45° field of view · fundus photo · 2352 by 1568 pixels:
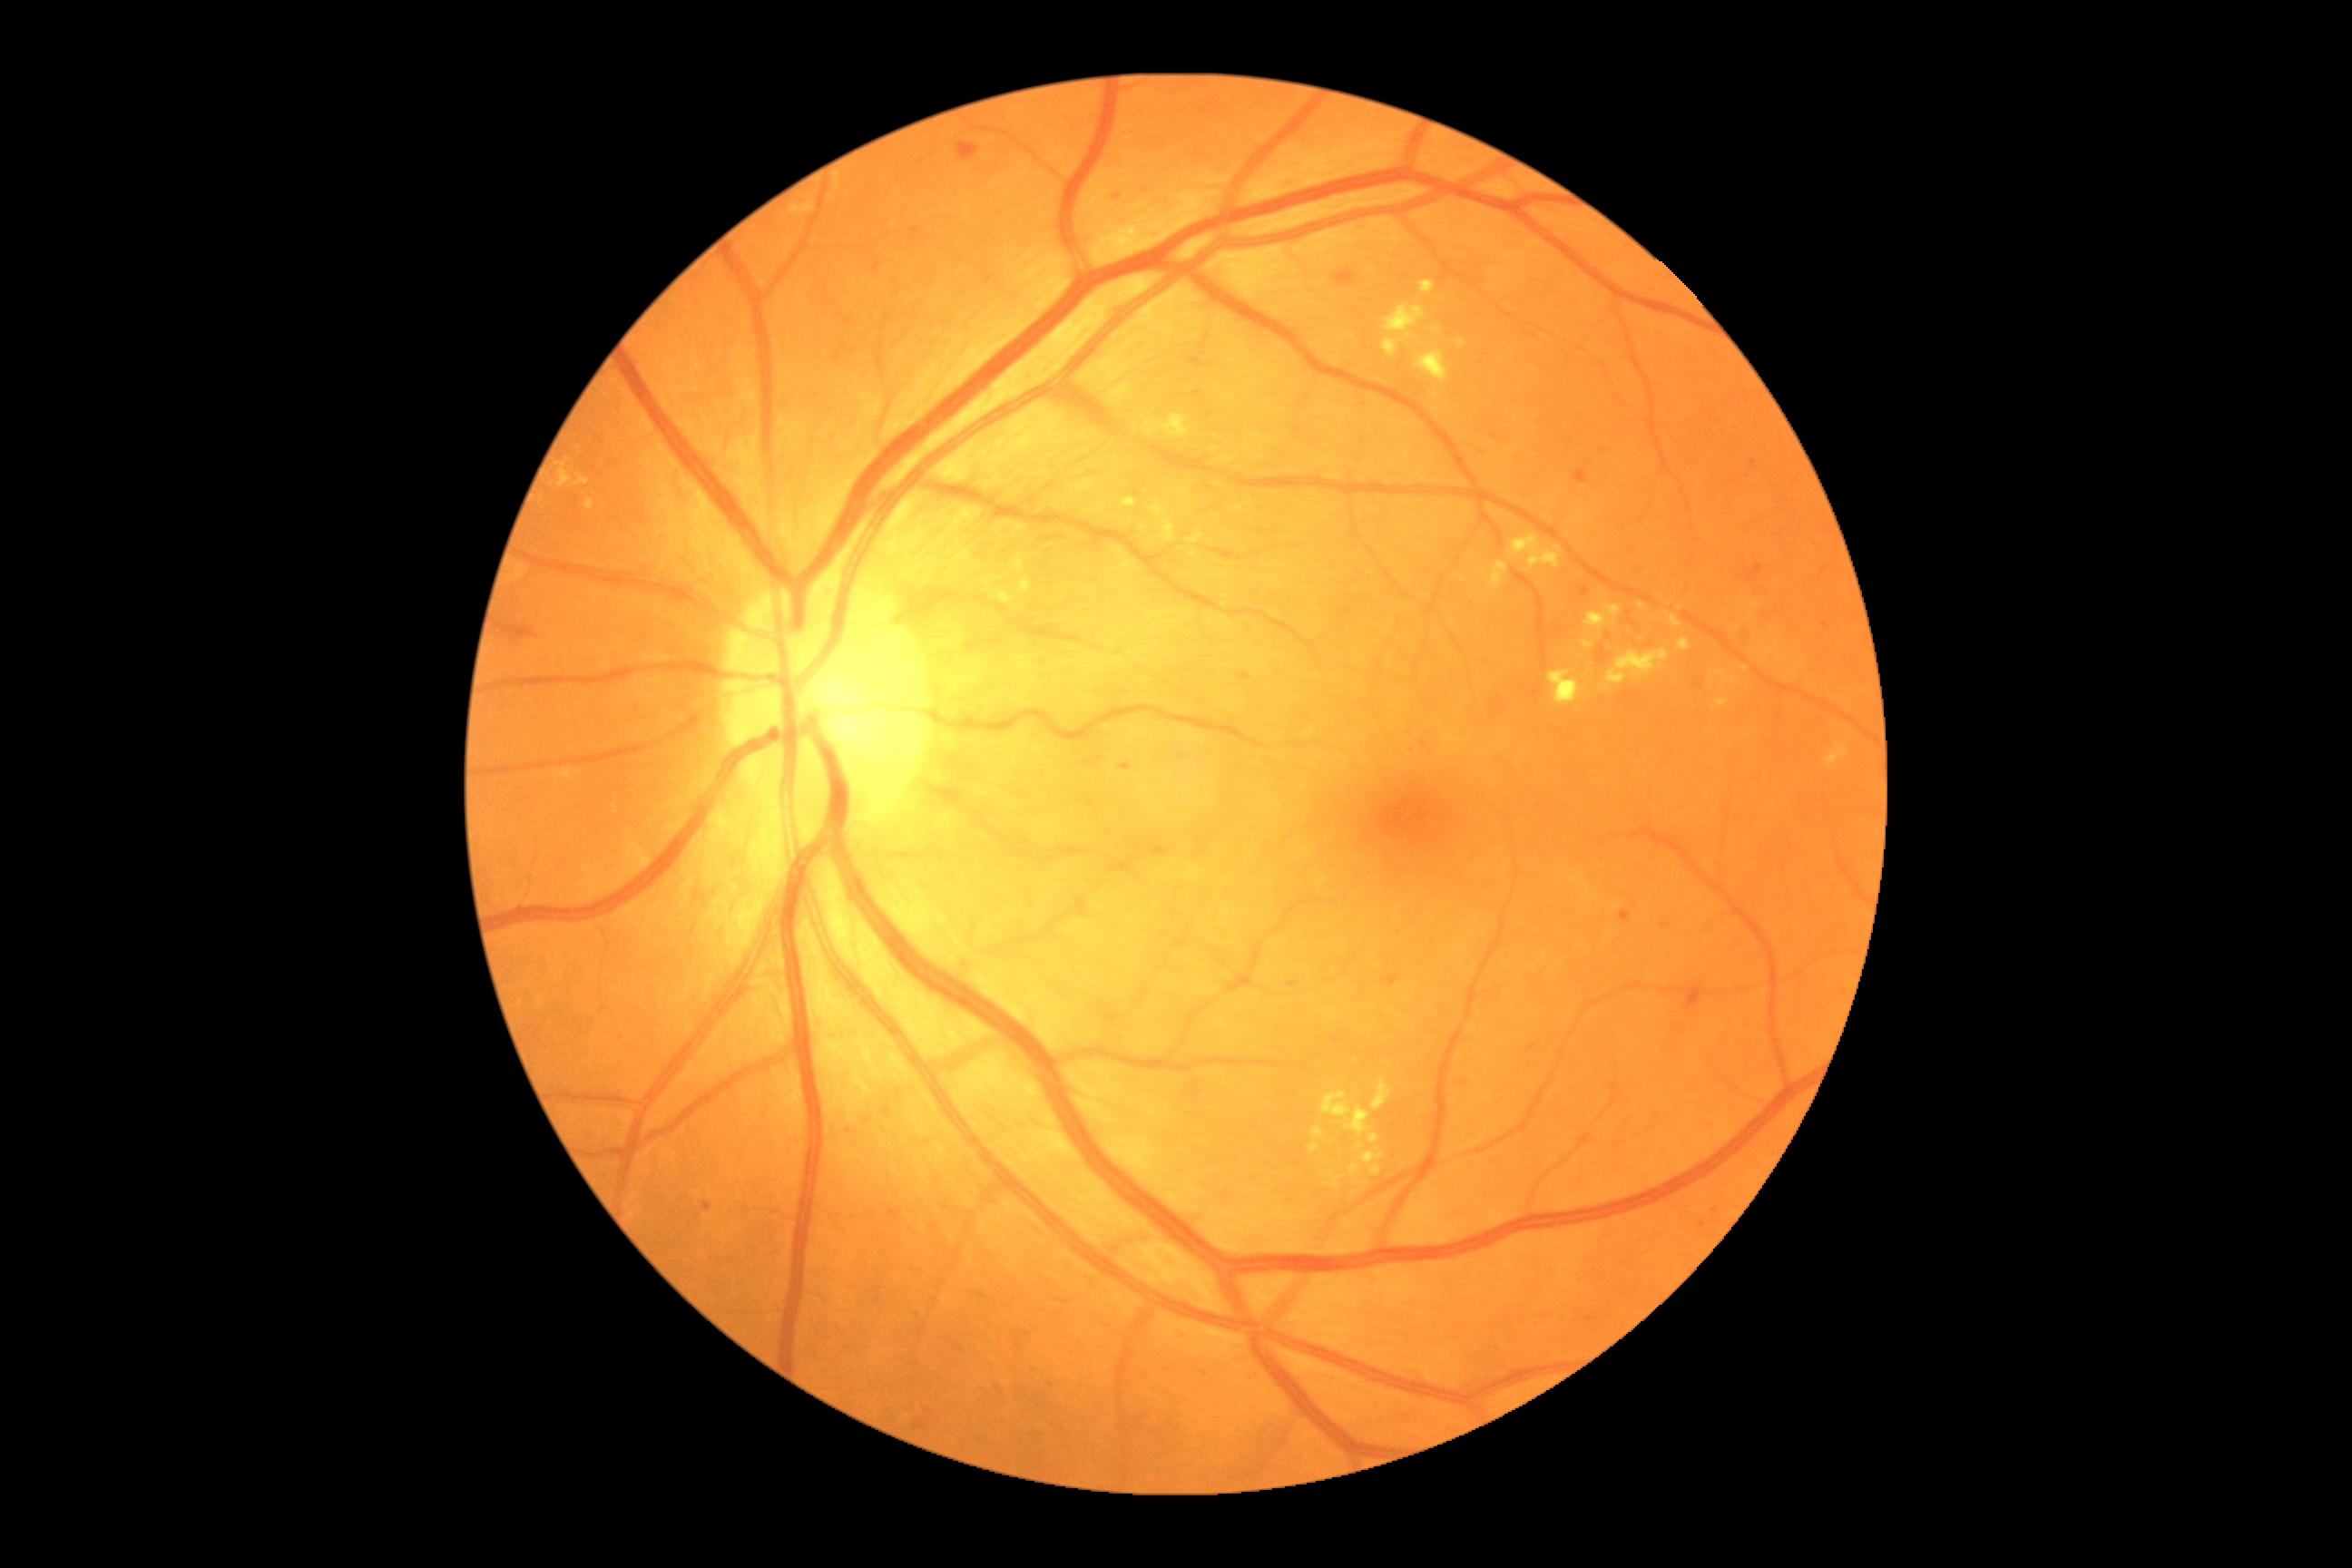 partial: true
dr_grade: 2
dr_grade_name: moderate NPDR
lesions:
  ex:
    - (x1=1150, y1=504, x2=1166, y2=518)
    - (x1=1547, y1=671, x2=1587, y2=707)
    - (x1=1188, y1=531, x2=1202, y2=545)
    - (x1=1181, y1=487, x2=1191, y2=498)
    - (x1=1716, y1=672, x2=1725, y2=676)
    - (x1=558, y1=458, x2=591, y2=487)
    - (x1=1211, y1=447, x2=1219, y2=453)
    - (x1=1309, y1=1144, x2=1320, y2=1153)
    - (x1=1456, y1=338, x2=1465, y2=348)
    - (x1=1825, y1=743, x2=1848, y2=769)
    - (x1=1607, y1=649, x2=1671, y2=685)
    - (x1=1714, y1=698, x2=1729, y2=710)
    - (x1=995, y1=593, x2=1012, y2=602)
    - (x1=1665, y1=612, x2=1683, y2=631)
    - (x1=1582, y1=642, x2=1594, y2=651)
  ex_small:
    - (x=1607, y=688)
    - (x=1436, y=331)
  ma:
    - (x1=1119, y1=763, x2=1132, y2=772)
    - (x1=1661, y1=921, x2=1672, y2=928)
    - (x1=1585, y1=1317, x2=1594, y2=1324)
    - (x1=1580, y1=589, x2=1589, y2=598)
    - (x1=1620, y1=910, x2=1631, y2=925)
    - (x1=1150, y1=845, x2=1166, y2=858)
    - (x1=1476, y1=447, x2=1487, y2=456)
  ma_small:
    - (x=1640, y=571)
    - (x=1703, y=1225)
    - (x=1825, y=624)
    - (x=1753, y=463)